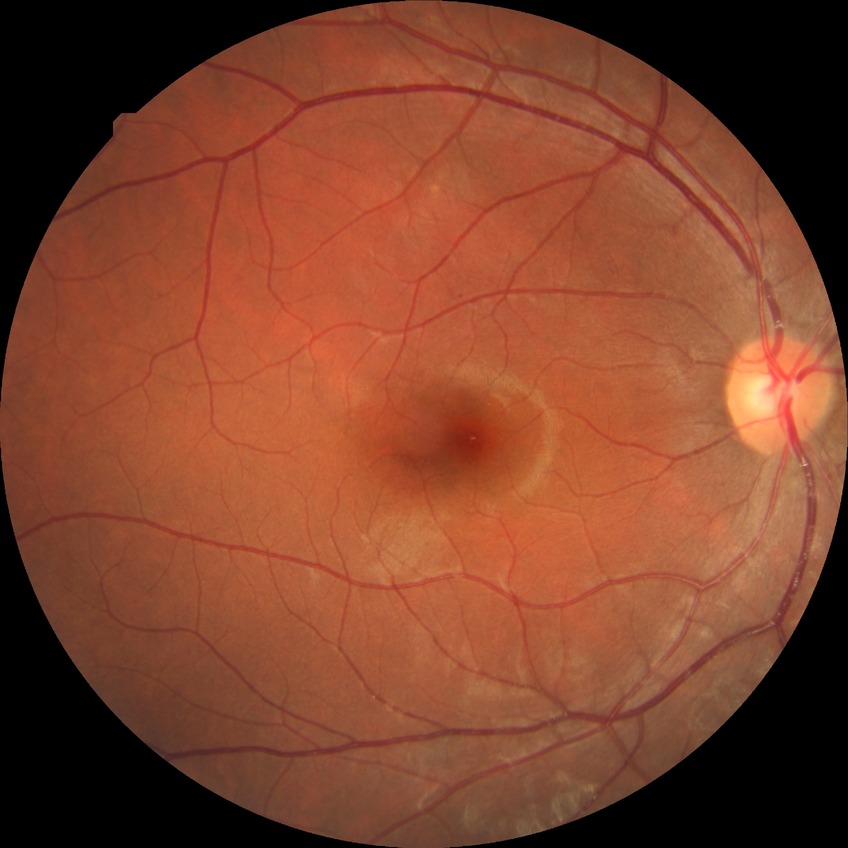
Disease class: non-proliferative diabetic retinopathy.
Diabetic retinopathy stage is simple diabetic retinopathy.